848x848px.
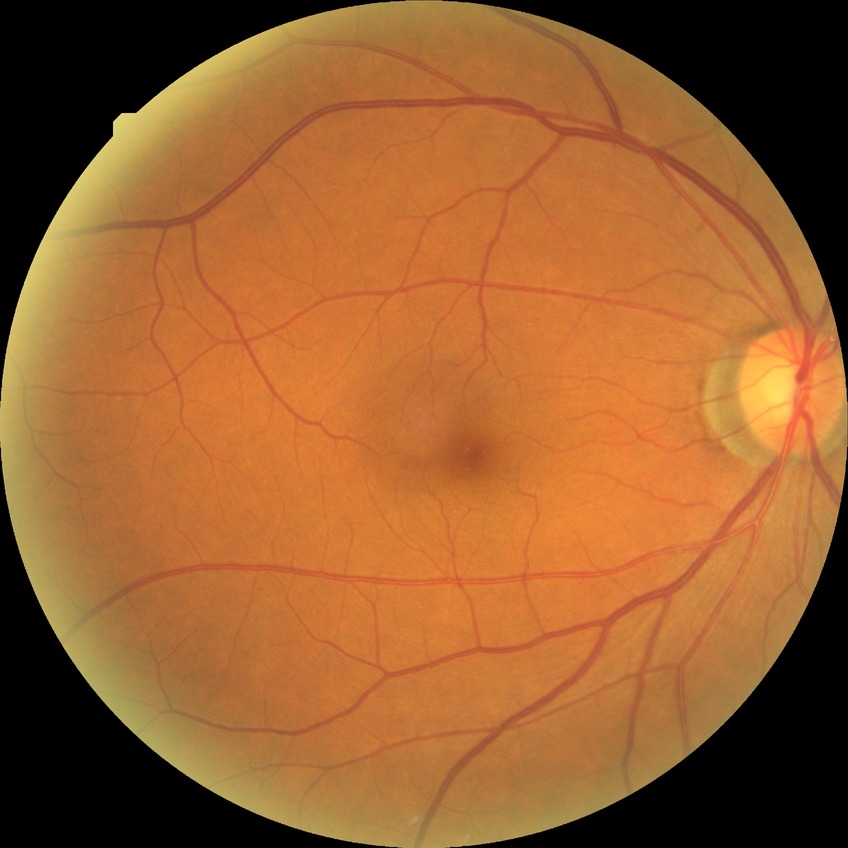

Diabetic retinopathy (DR): no diabetic retinopathy (NDR).